Nidek AFC-330. CFP. Centered on the optic disc.
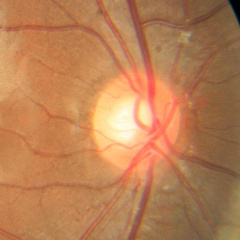
Showing no glaucomatous optic neuropathy.